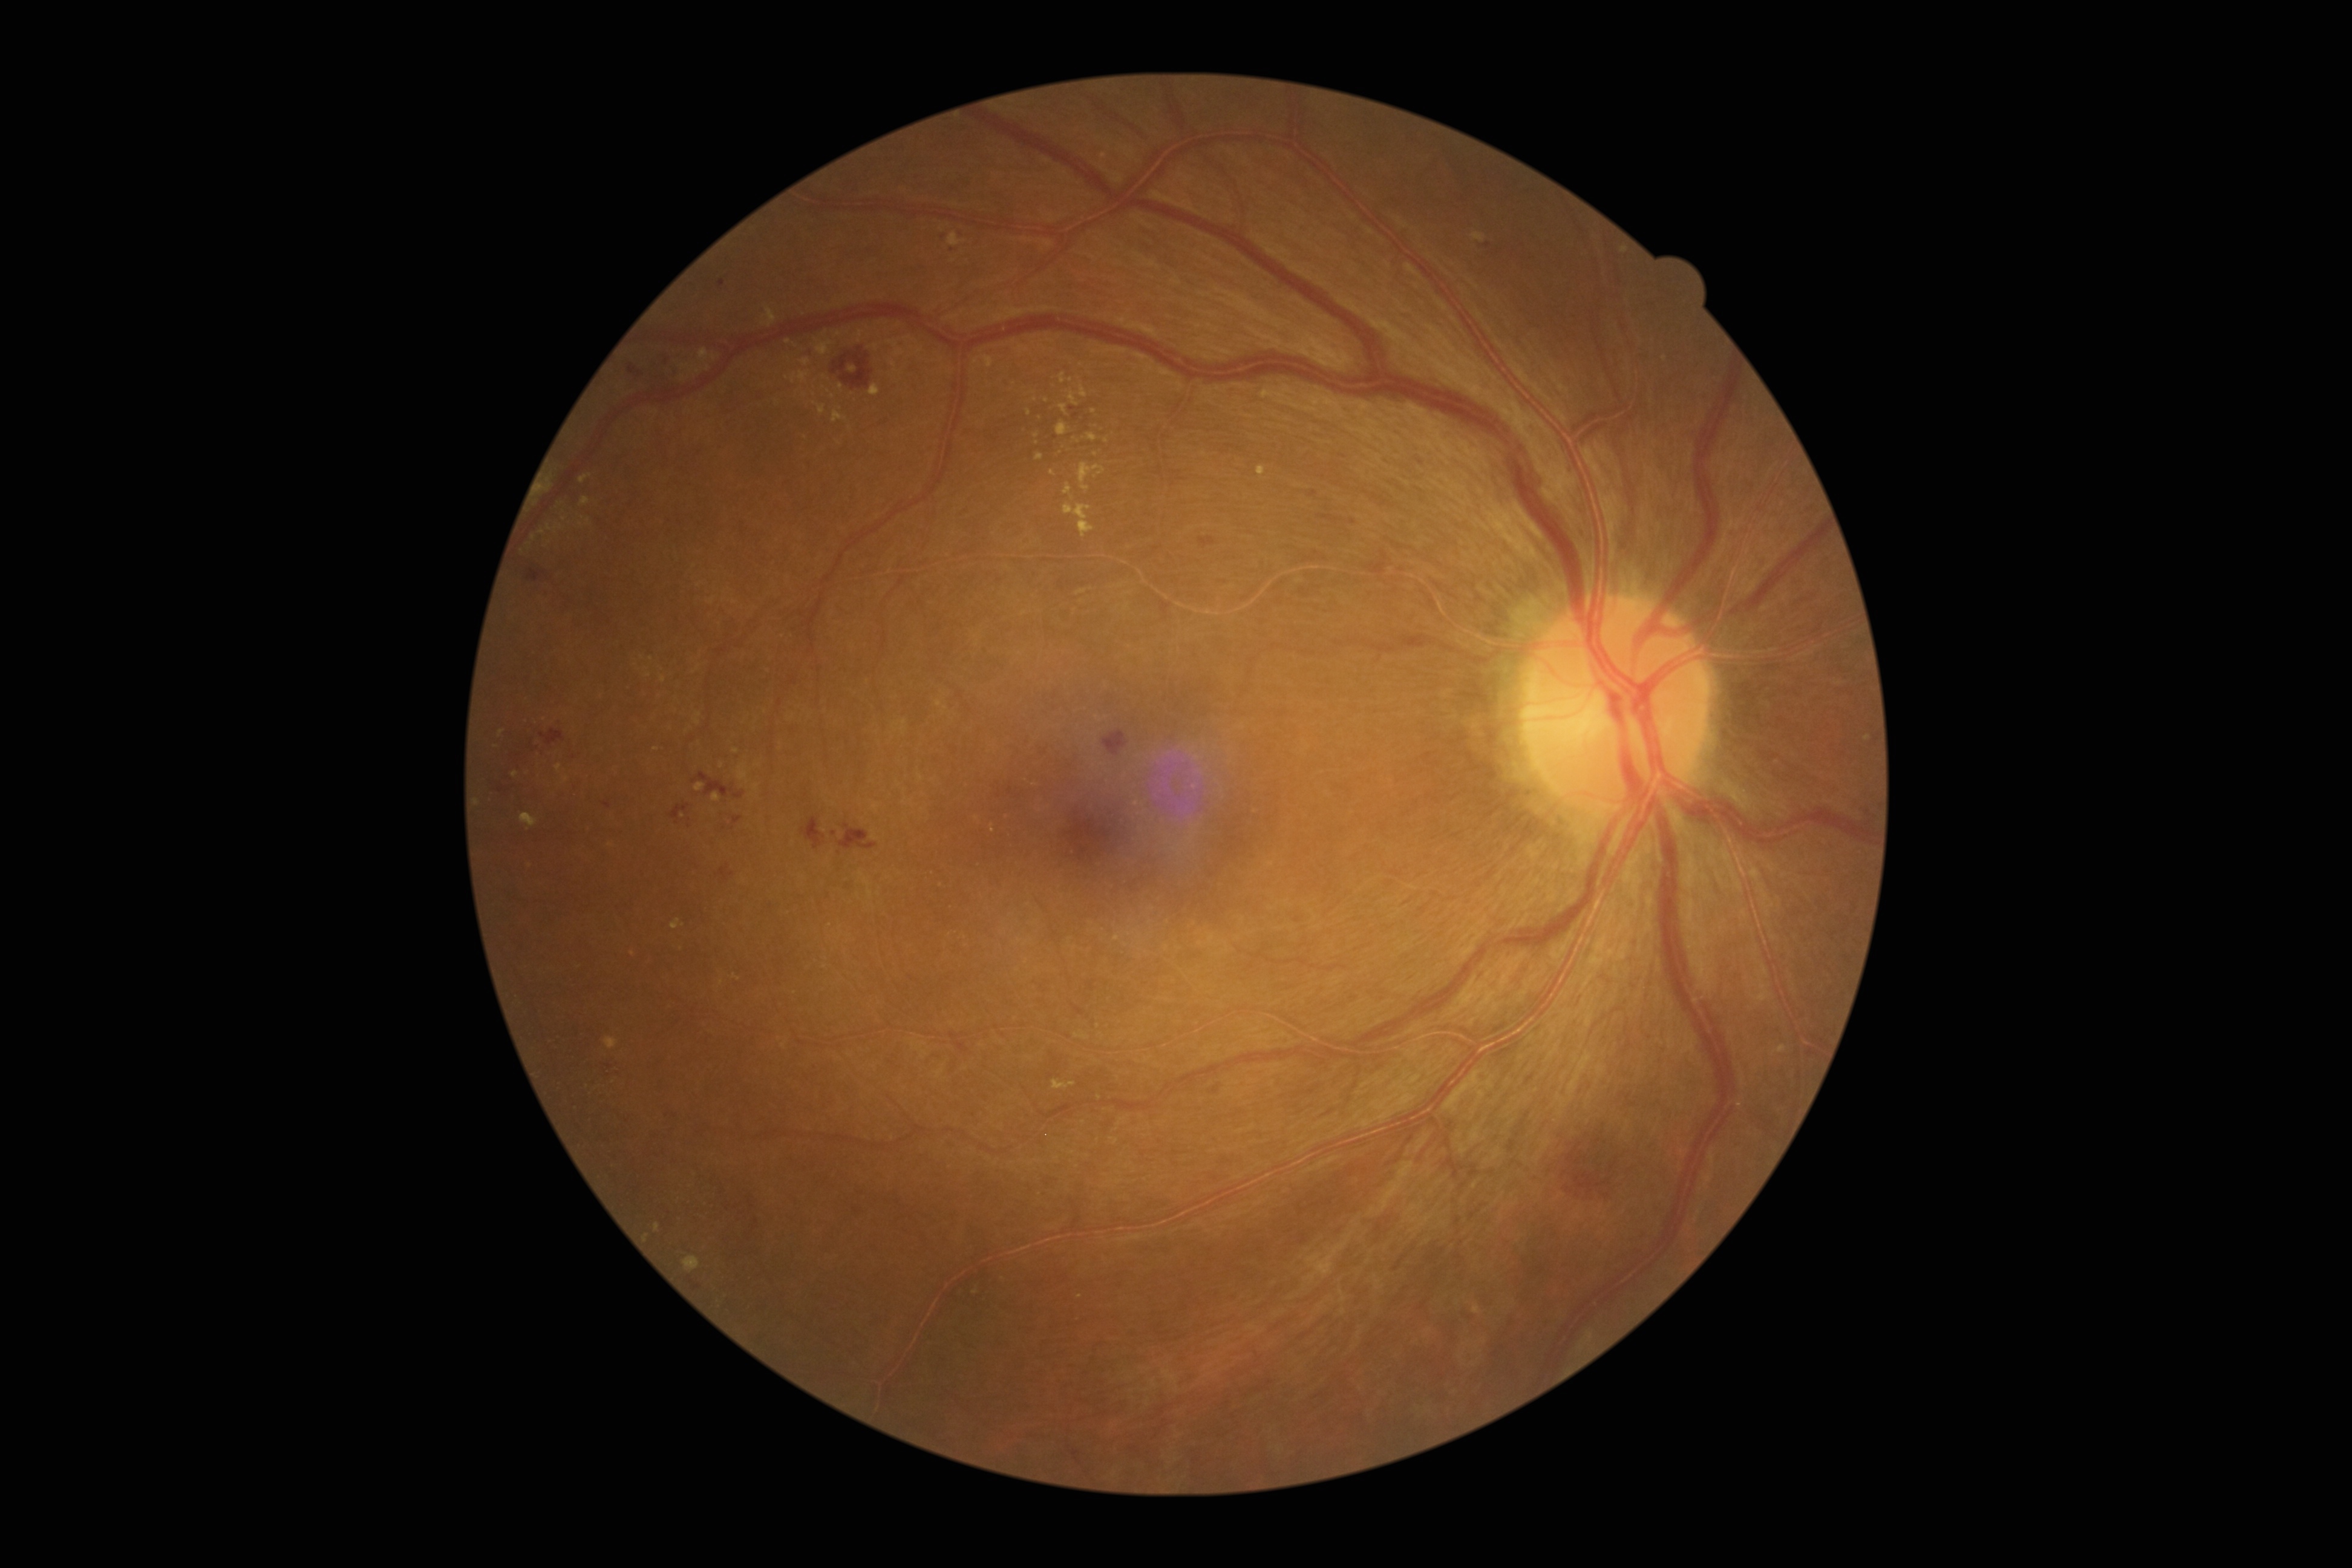
{"partial":true,"dr_grade":2,"dr_grade_name":"moderate NPDR","lesions":{"ex":[[760,307,777,327],[791,371,810,384],[579,474,591,483],[695,783,705,793],[538,479,551,495],[556,765,563,775],[1064,483,1075,500],[814,403,826,416],[1059,373,1067,384]],"ex_small_approx":[[909,340],[1080,1297],[736,752],[502,733],[1053,473],[1099,1098],[1106,441],[1136,804],[633,954],[1261,471]]}}